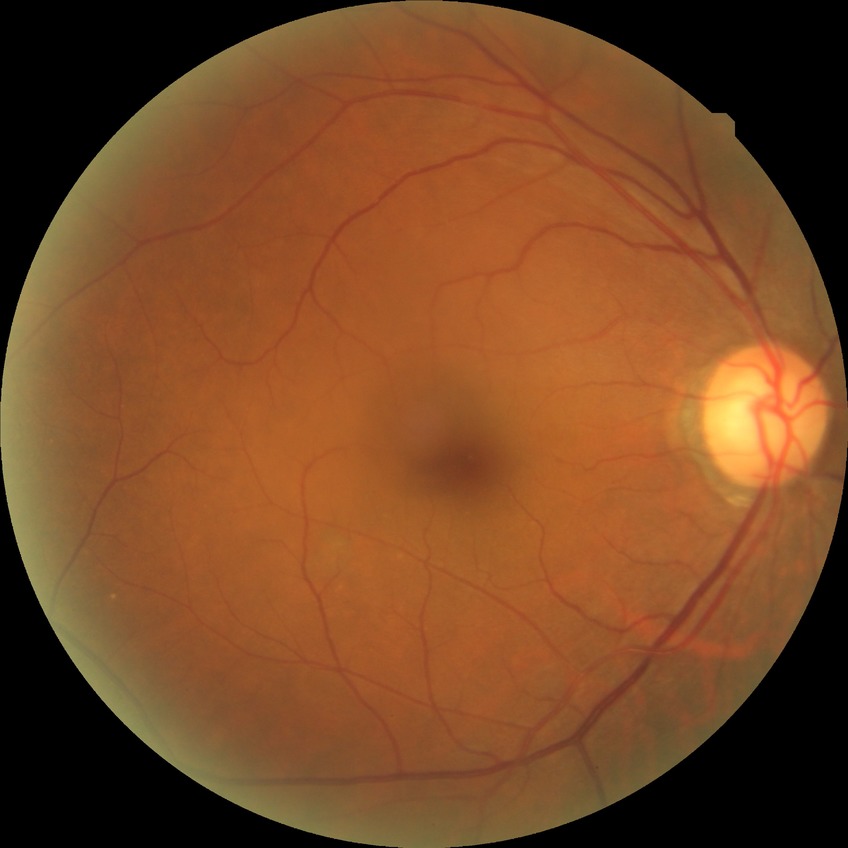

Modified Davis grading: no diabetic retinopathy.